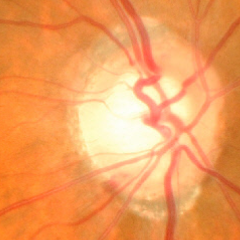
The image shows severe glaucomatous damage.